45° field of view; 2048x1536; color fundus photograph.
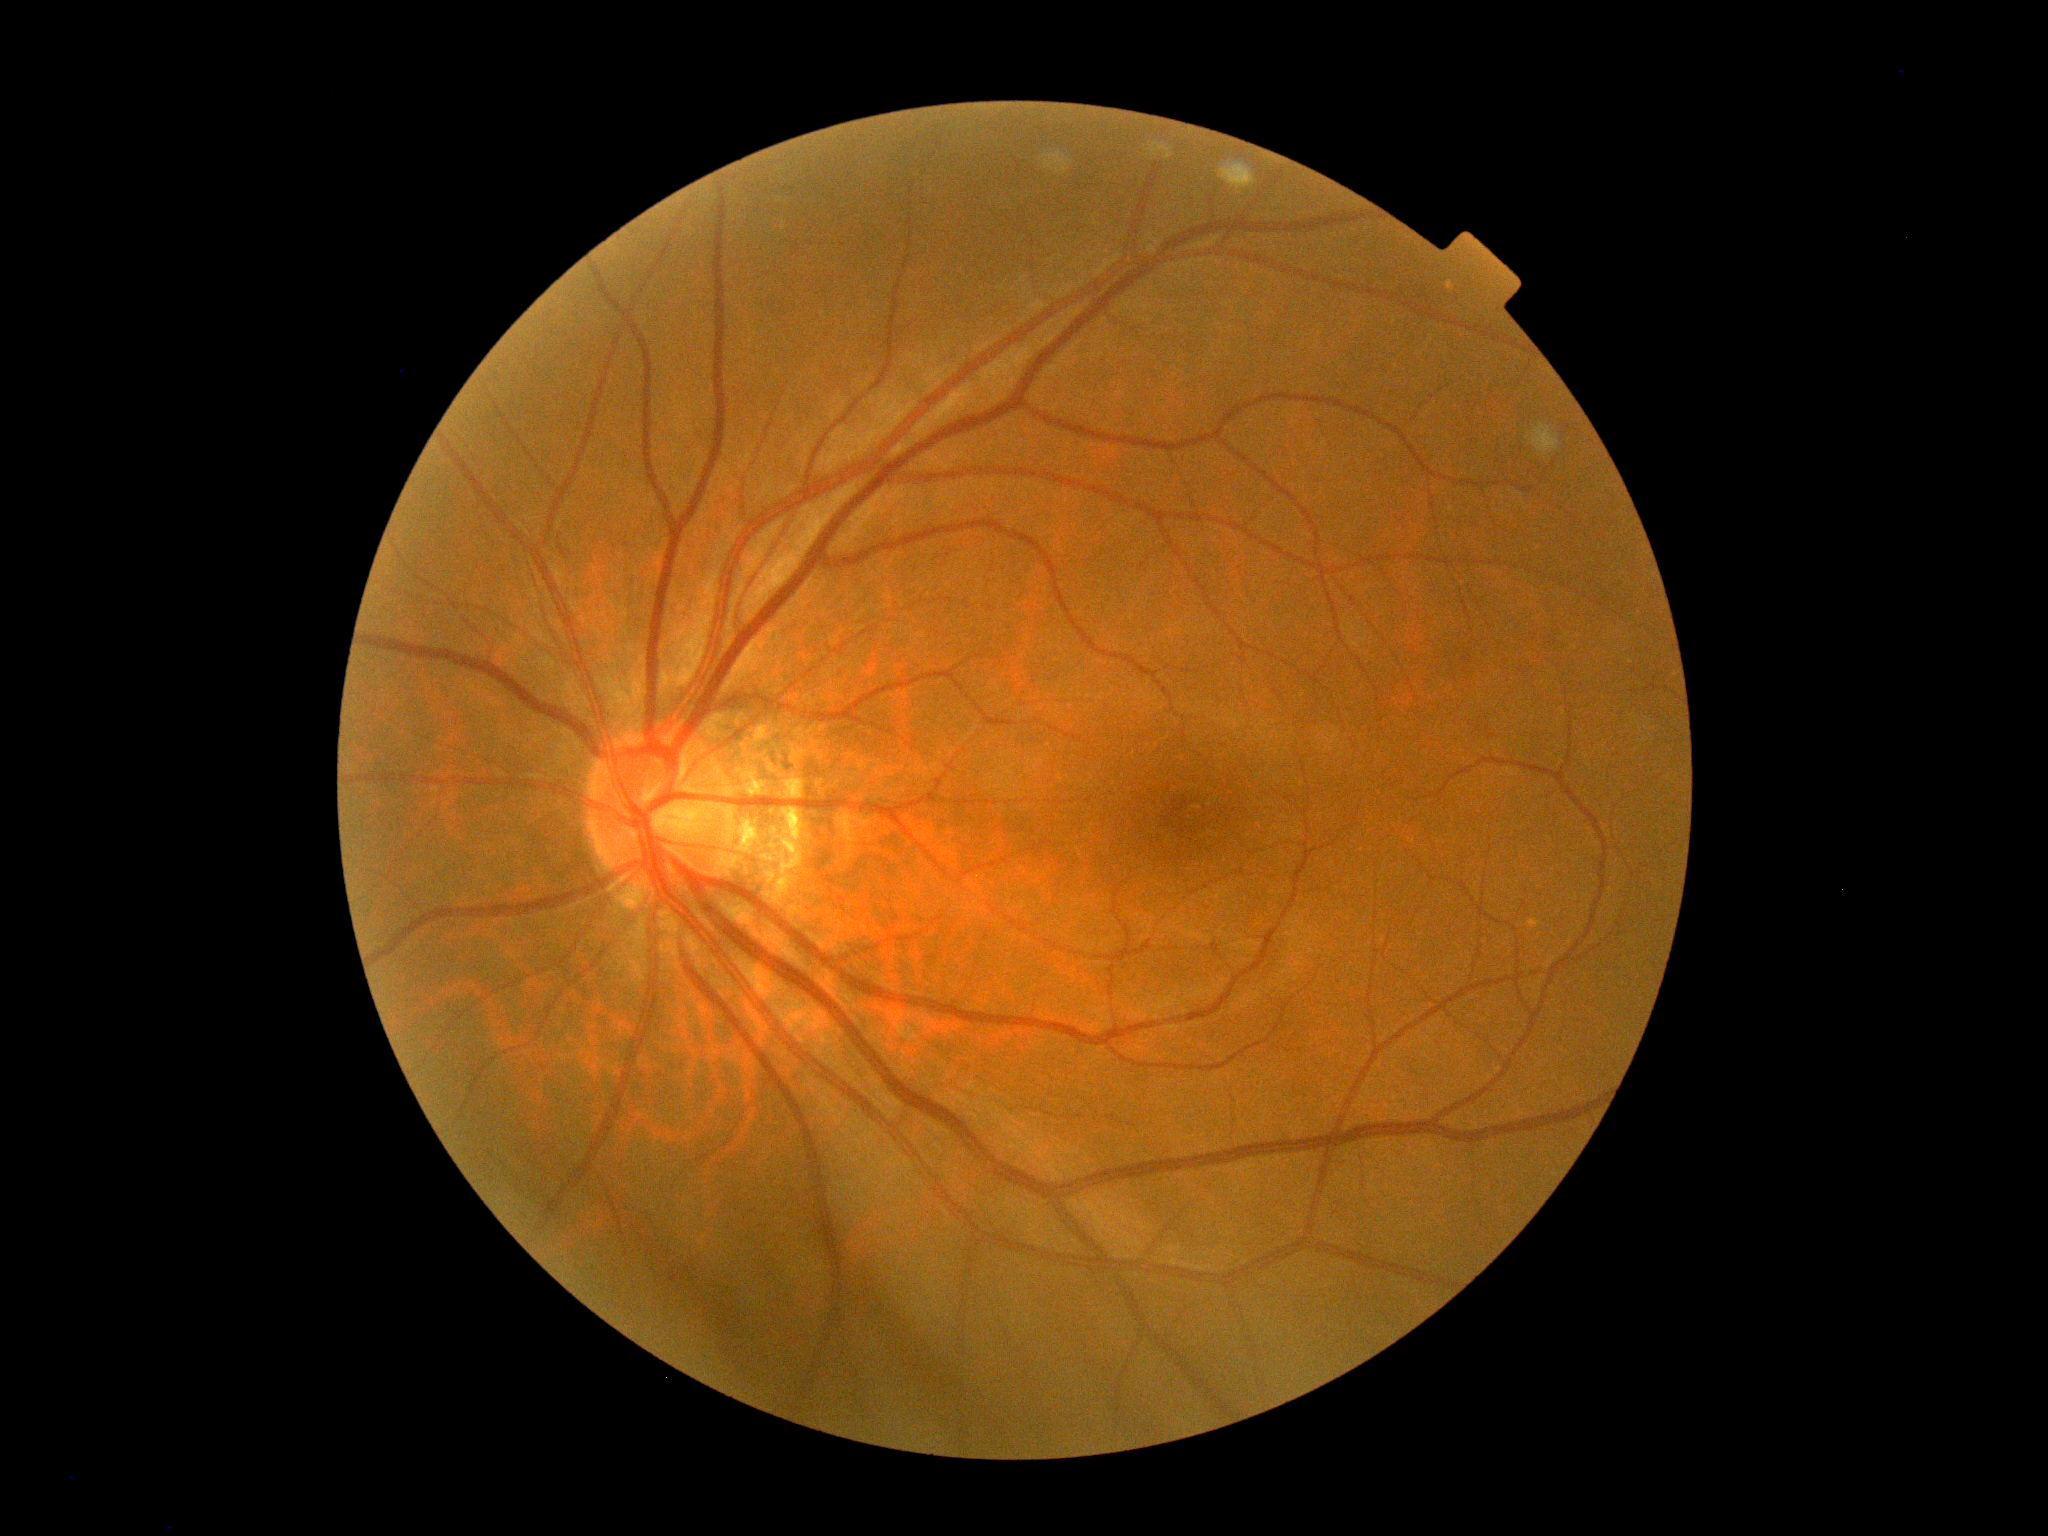
No signs of diabetic retinopathy. DR severity is grade 0 (no apparent retinopathy) — no visible signs of diabetic retinopathy.